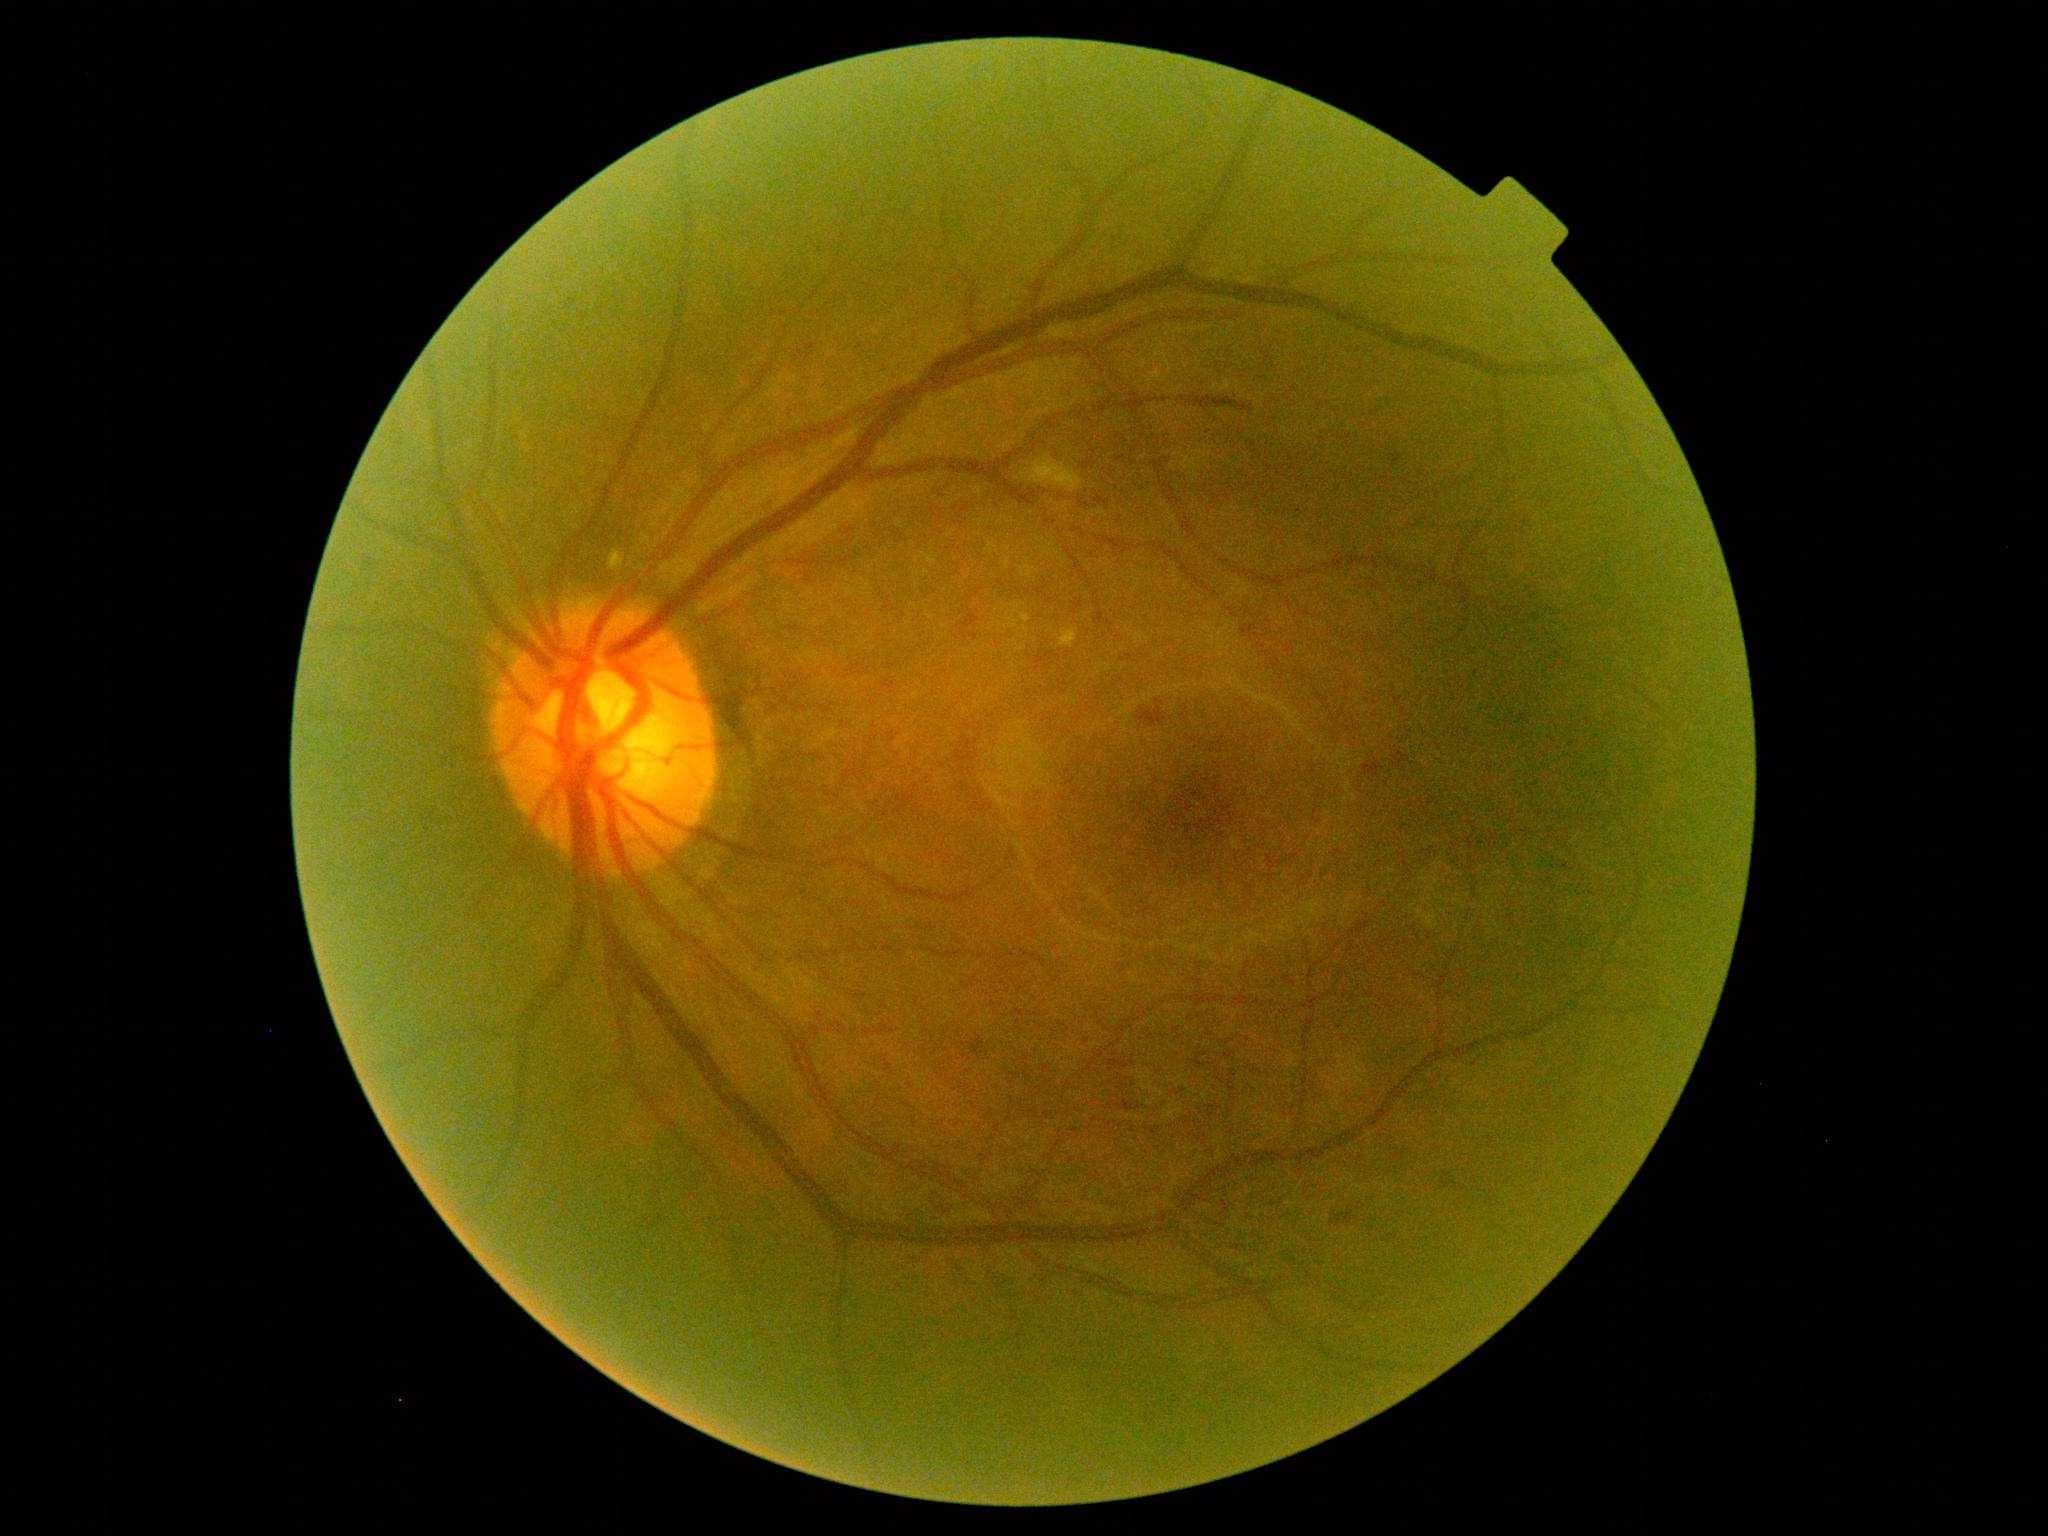 DR severity = grade 2.